No pharmacologic dilation
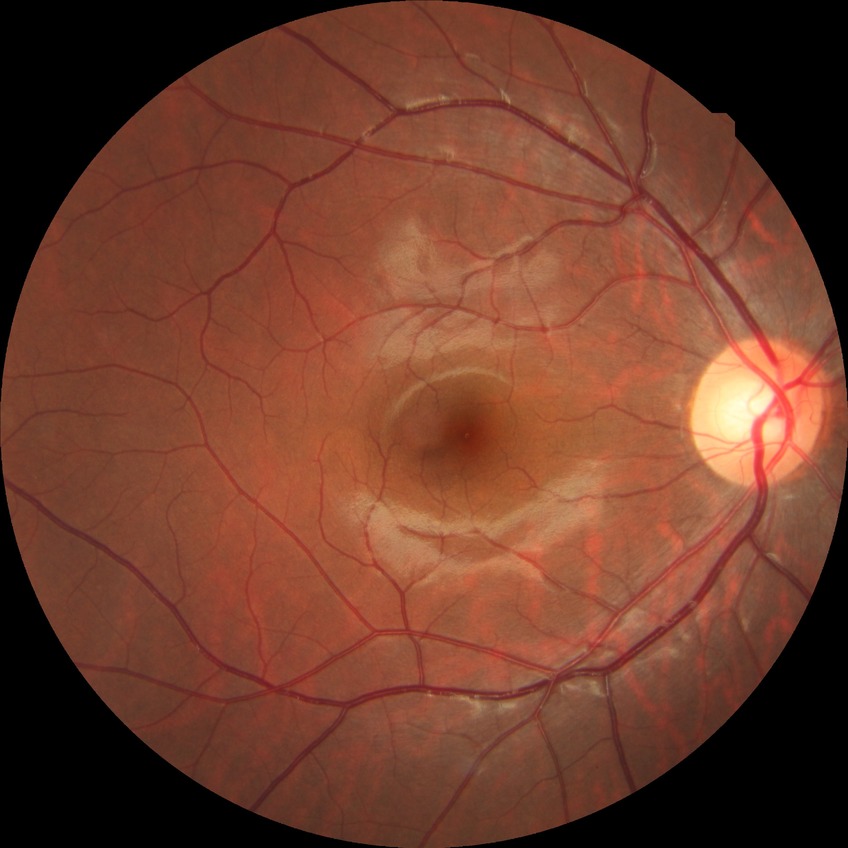

davis_grade: NDR (no diabetic retinopathy)